Pediatric wide-field fundus photograph
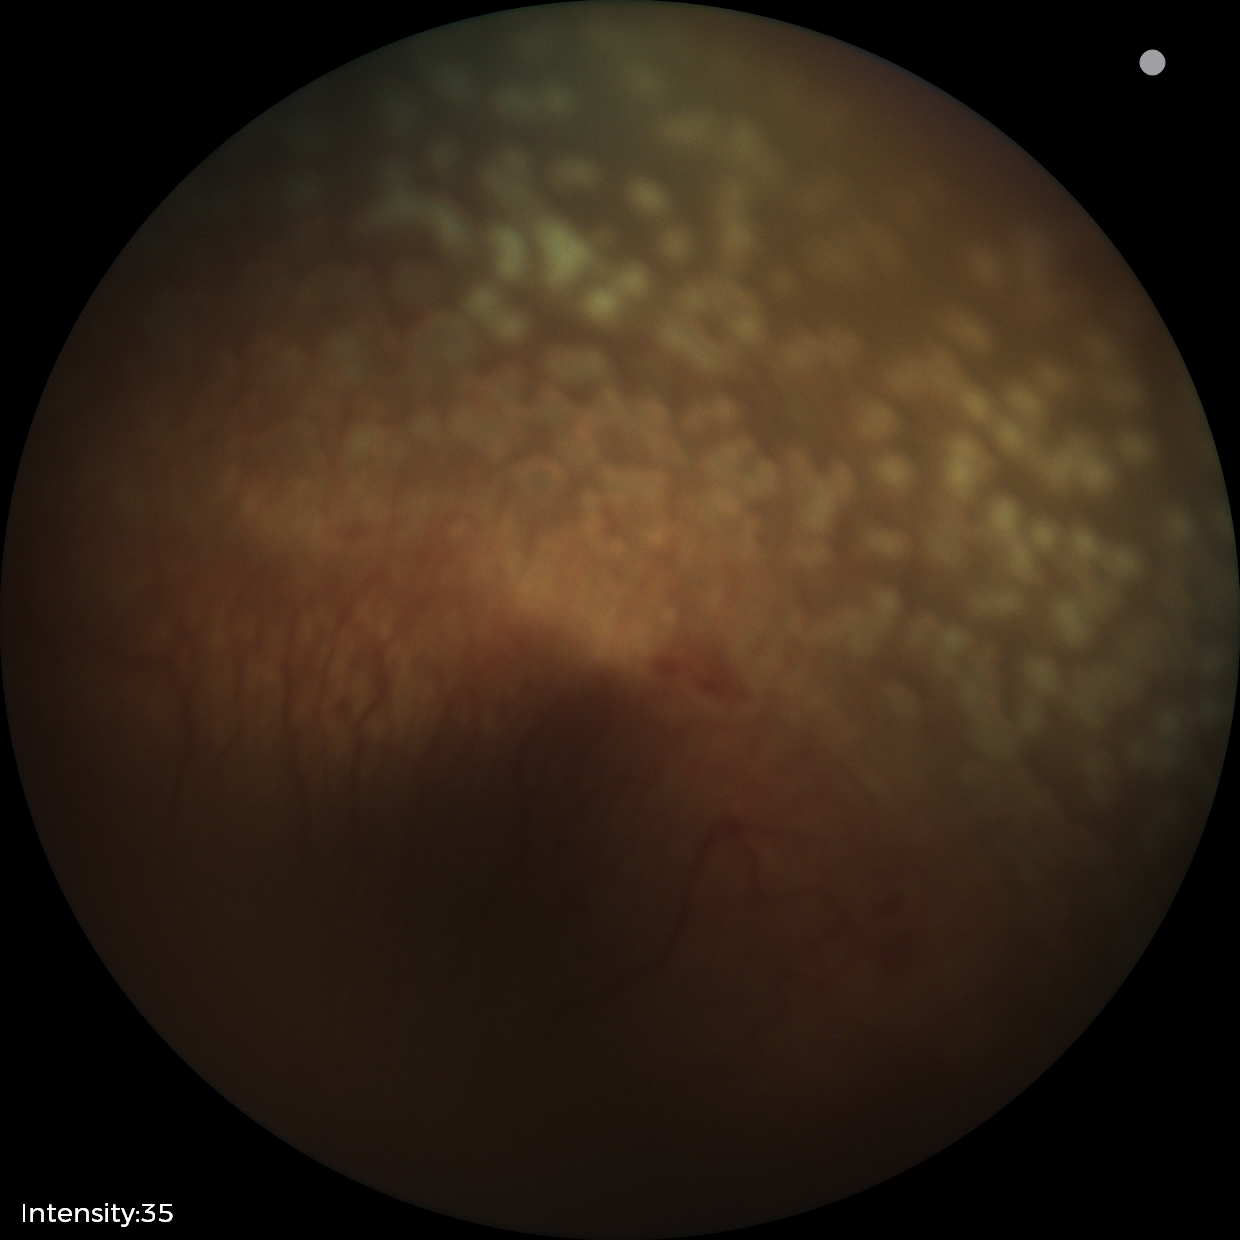
Retinopathy of prematurity: stage 2